Image size 2352x1568; 45° field of view.
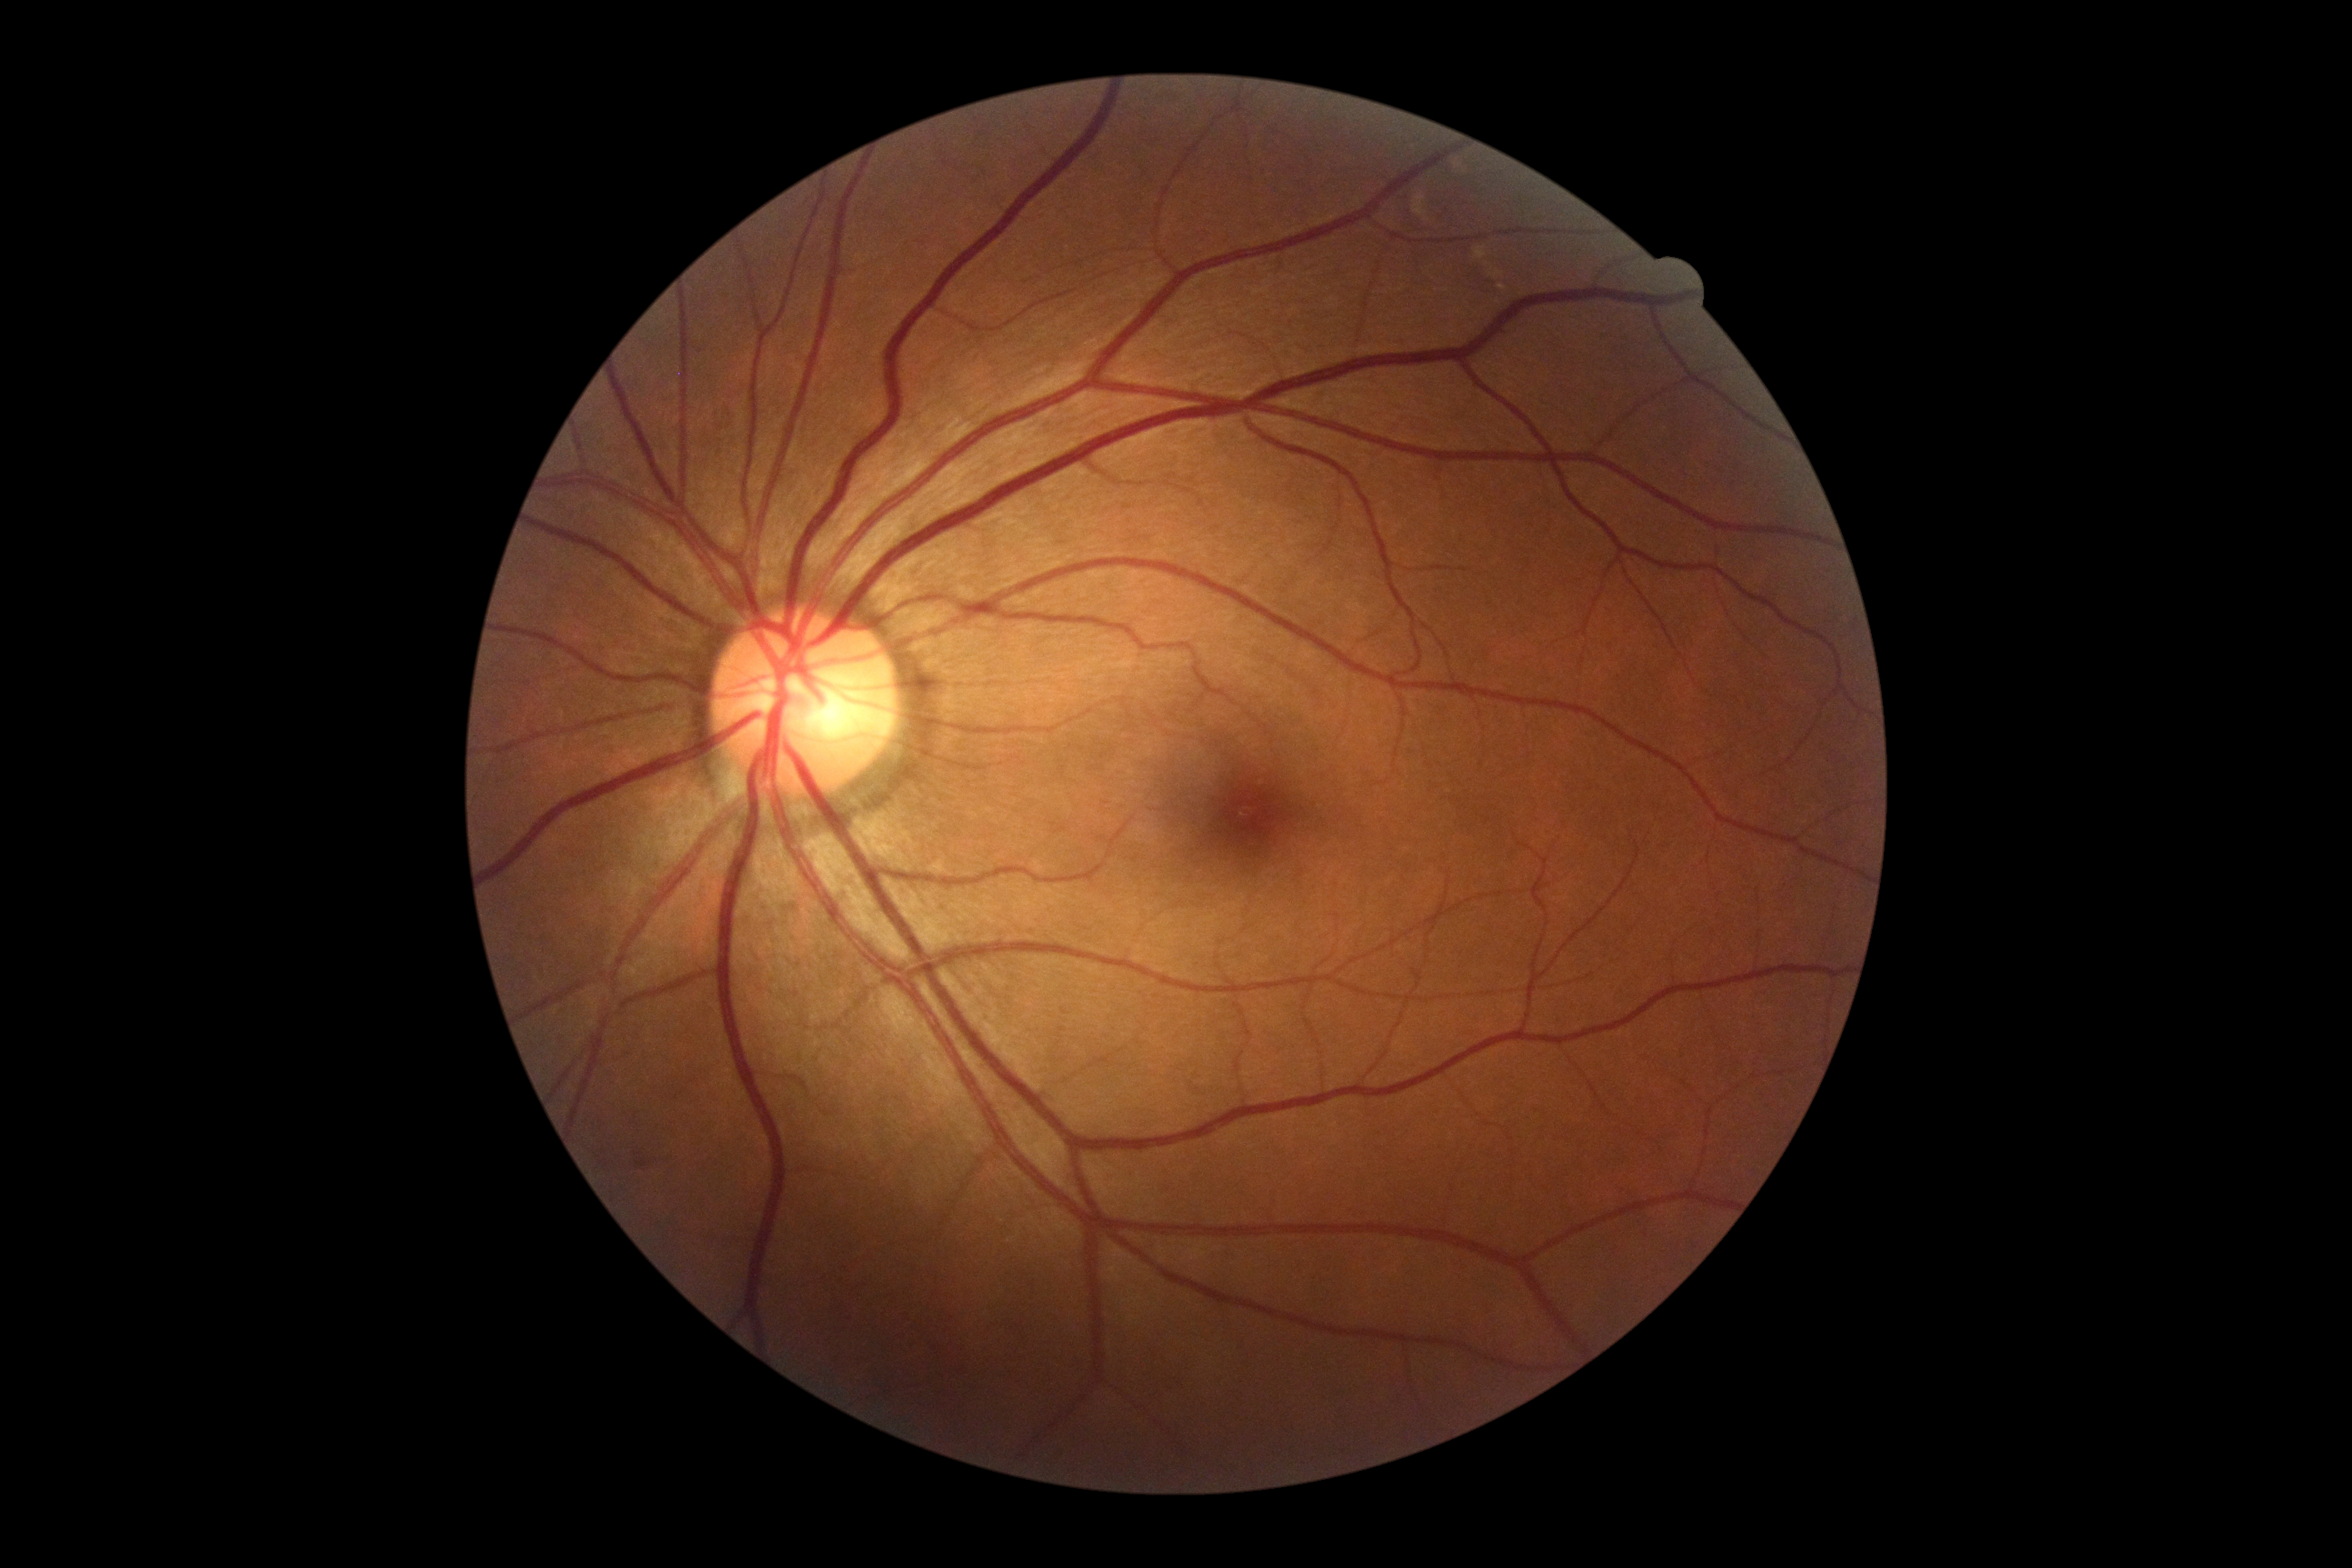

No DR findings.
Diabetic retinopathy: 0/4 — no visible signs of diabetic retinopathy.